Image size 2352x1568
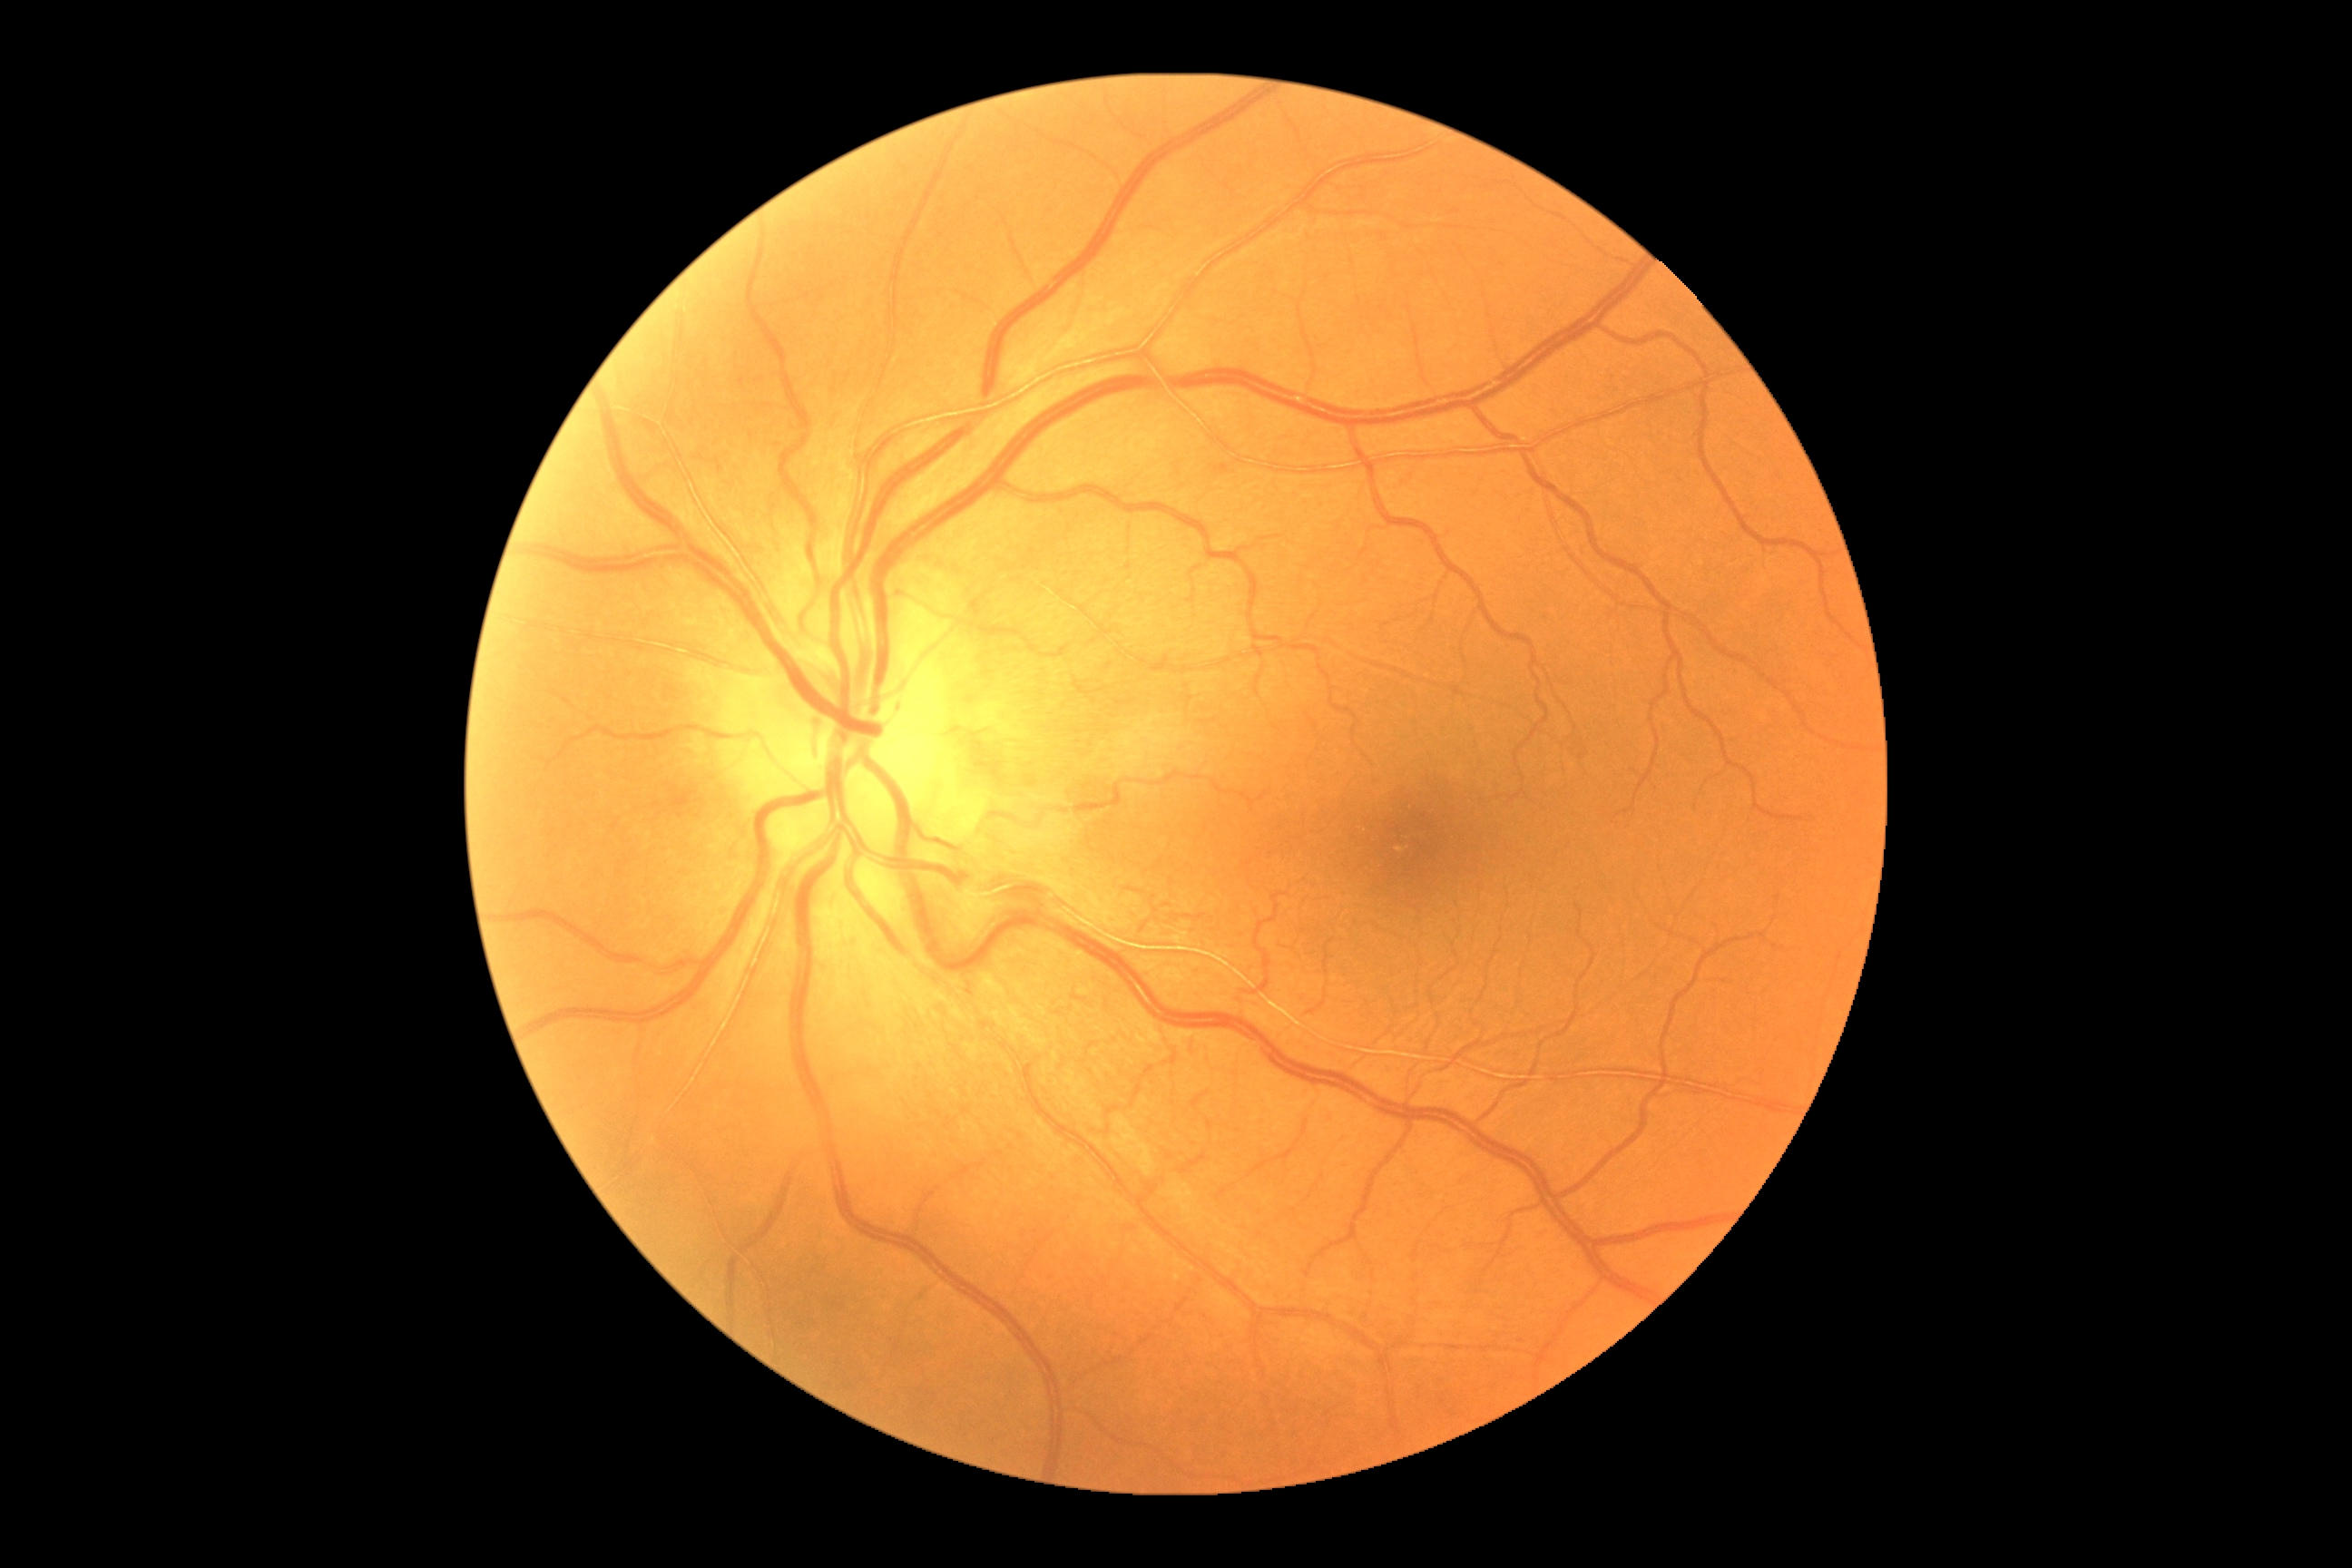 {"dr_grade": "0"}